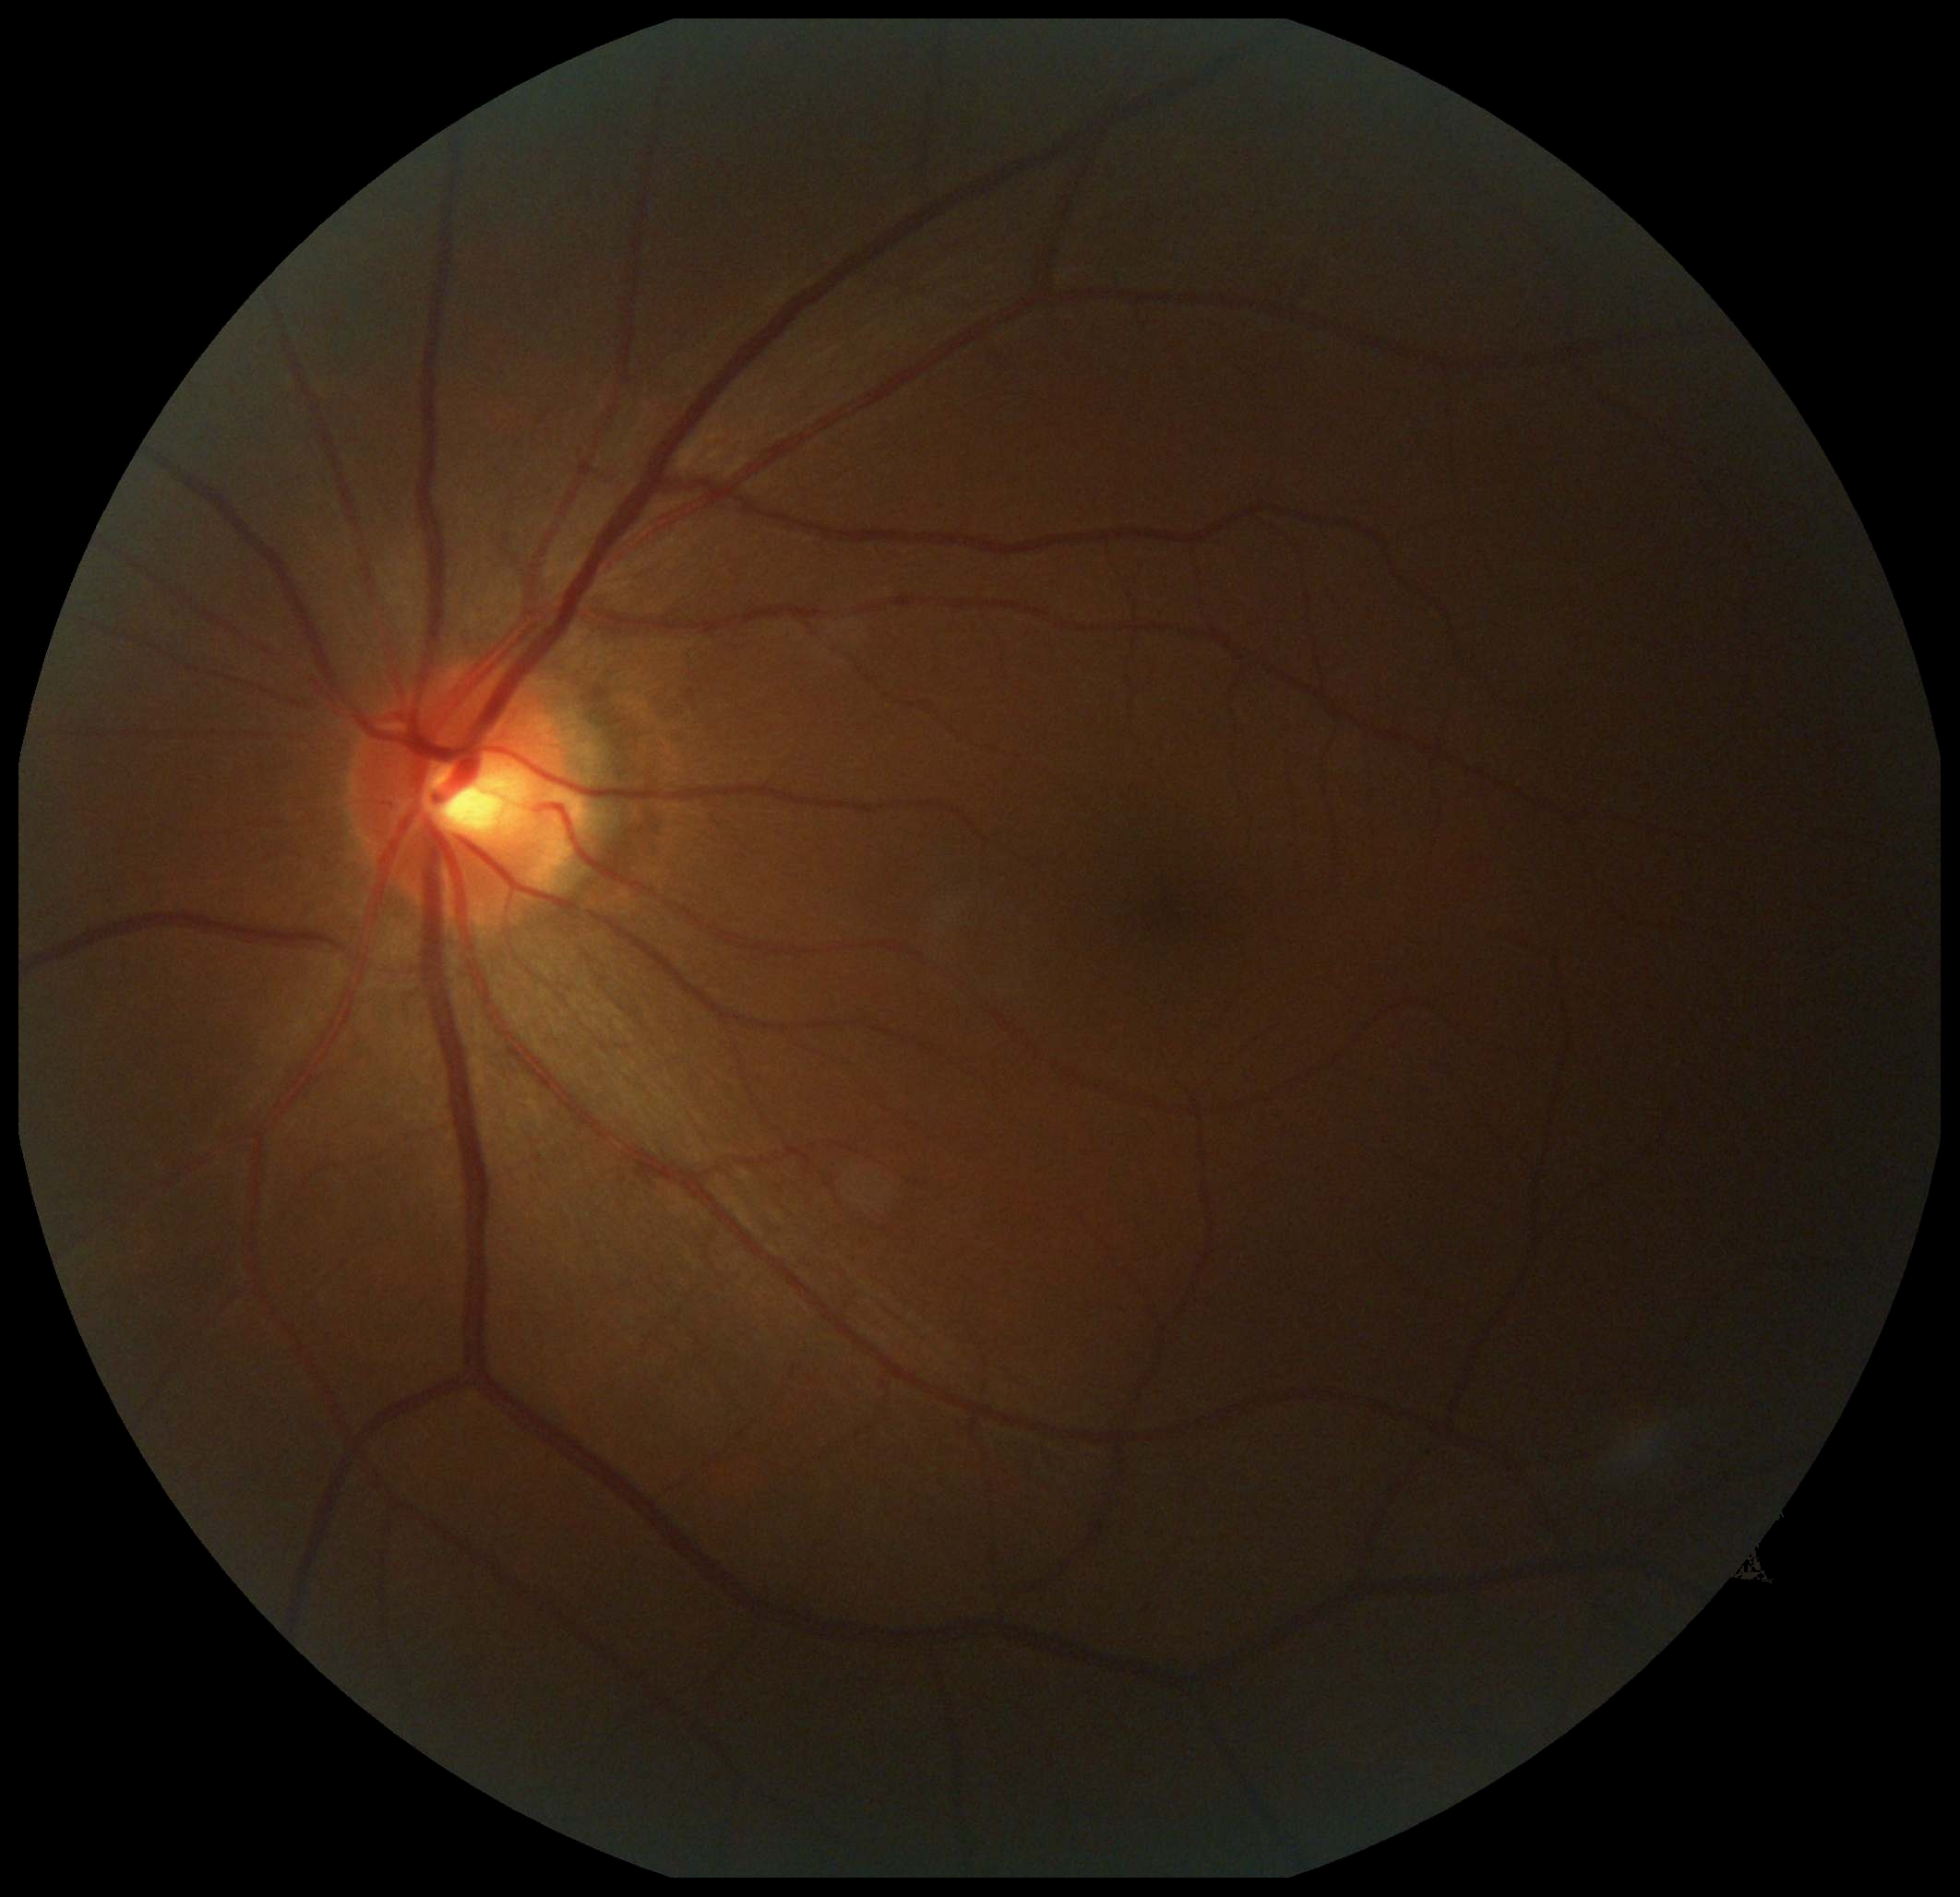
diabetic retinopathy (DR) = no apparent retinopathy (grade 0), DR impression = negative for DR.